NIDEK AFC-230 · 45 degree fundus photograph · color fundus image · nonmydriatic
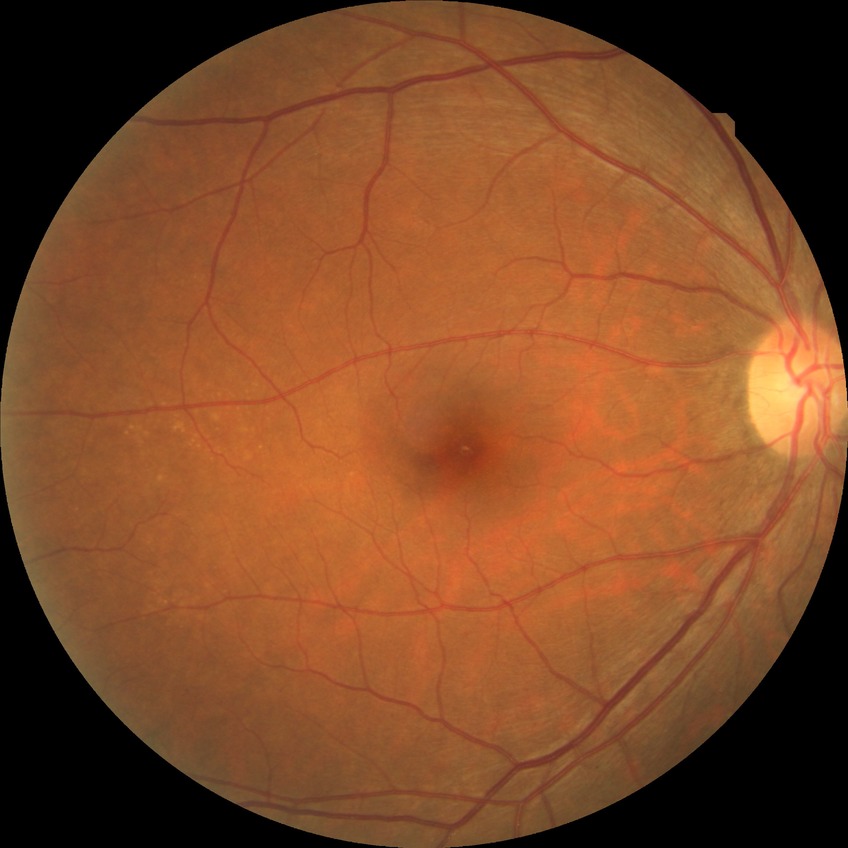
{
  "davis_grade": "no diabetic retinopathy"
}